Graded on the modified Davis scale:
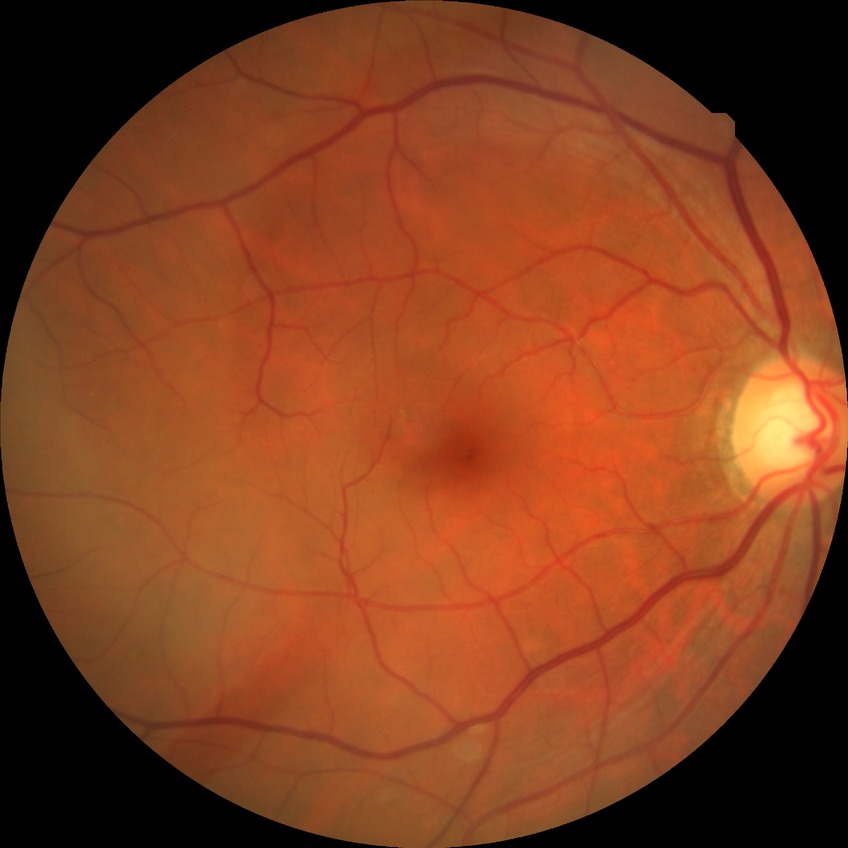

Diabetic retinopathy (DR): NDR (no diabetic retinopathy).